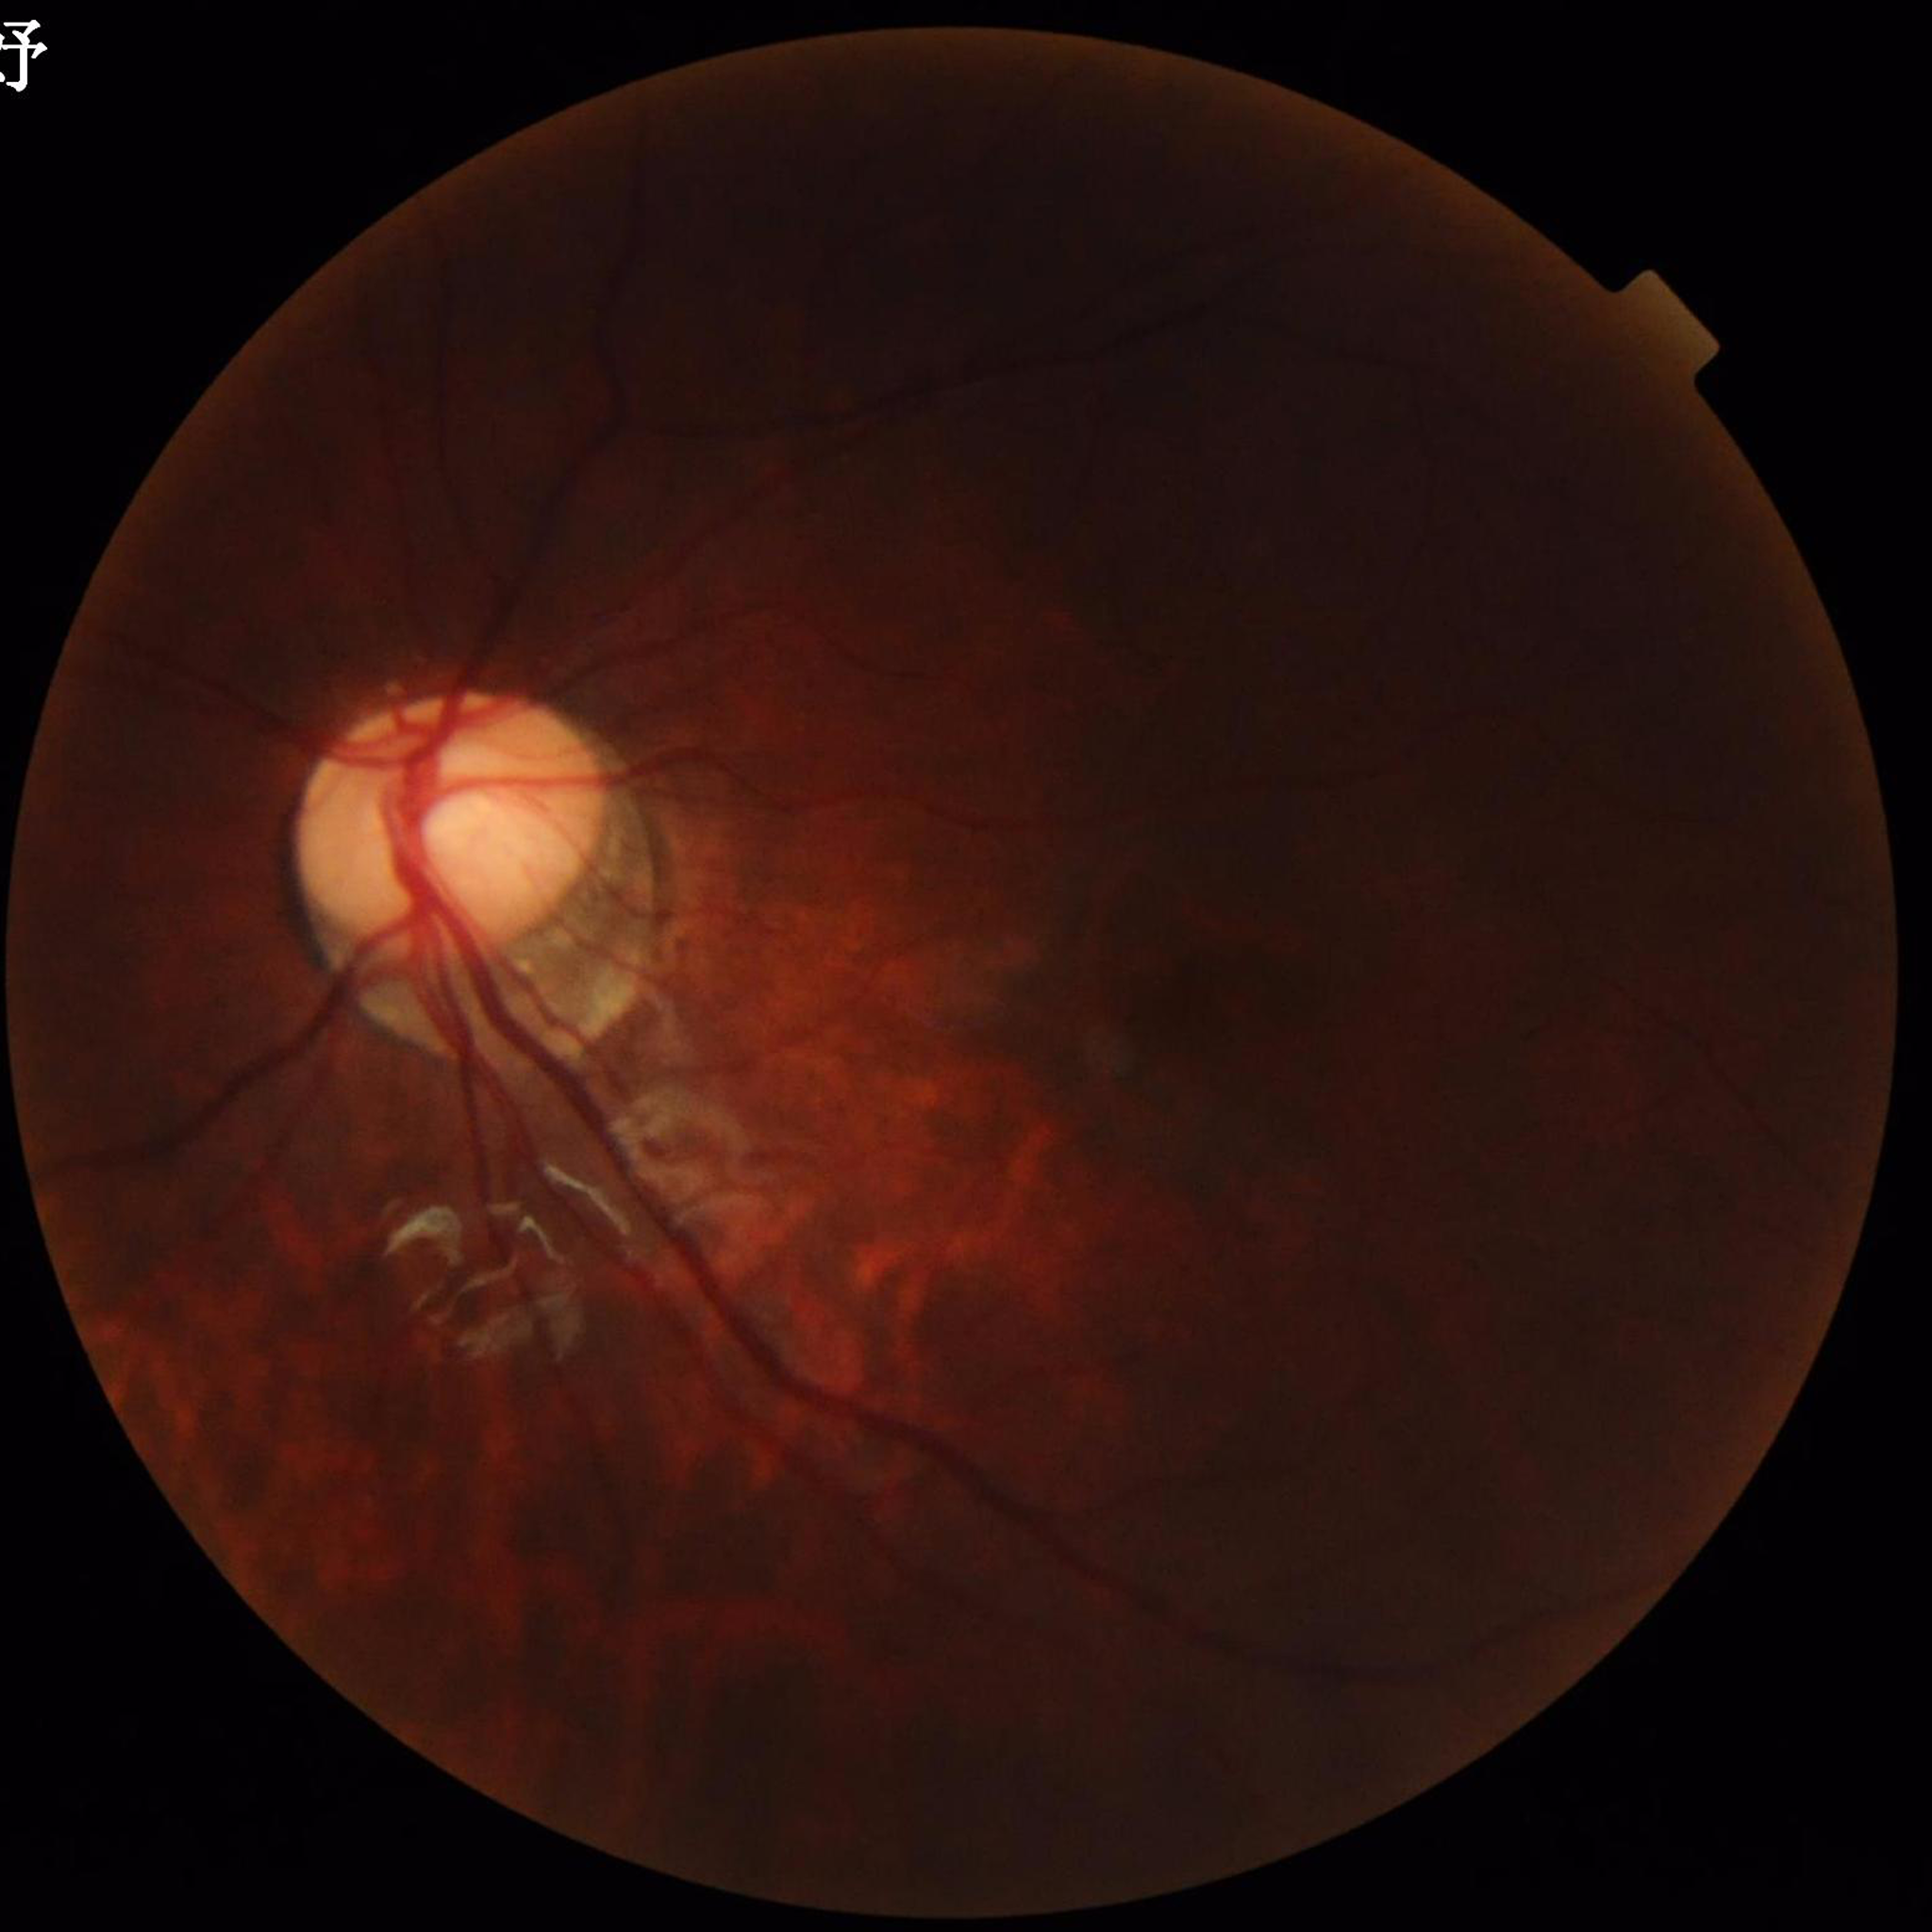
{
  "image_quality": "reduced — illumination/color distortion, blur",
  "diagnosis": "no AMD, diabetic retinopathy, or glaucoma"
}